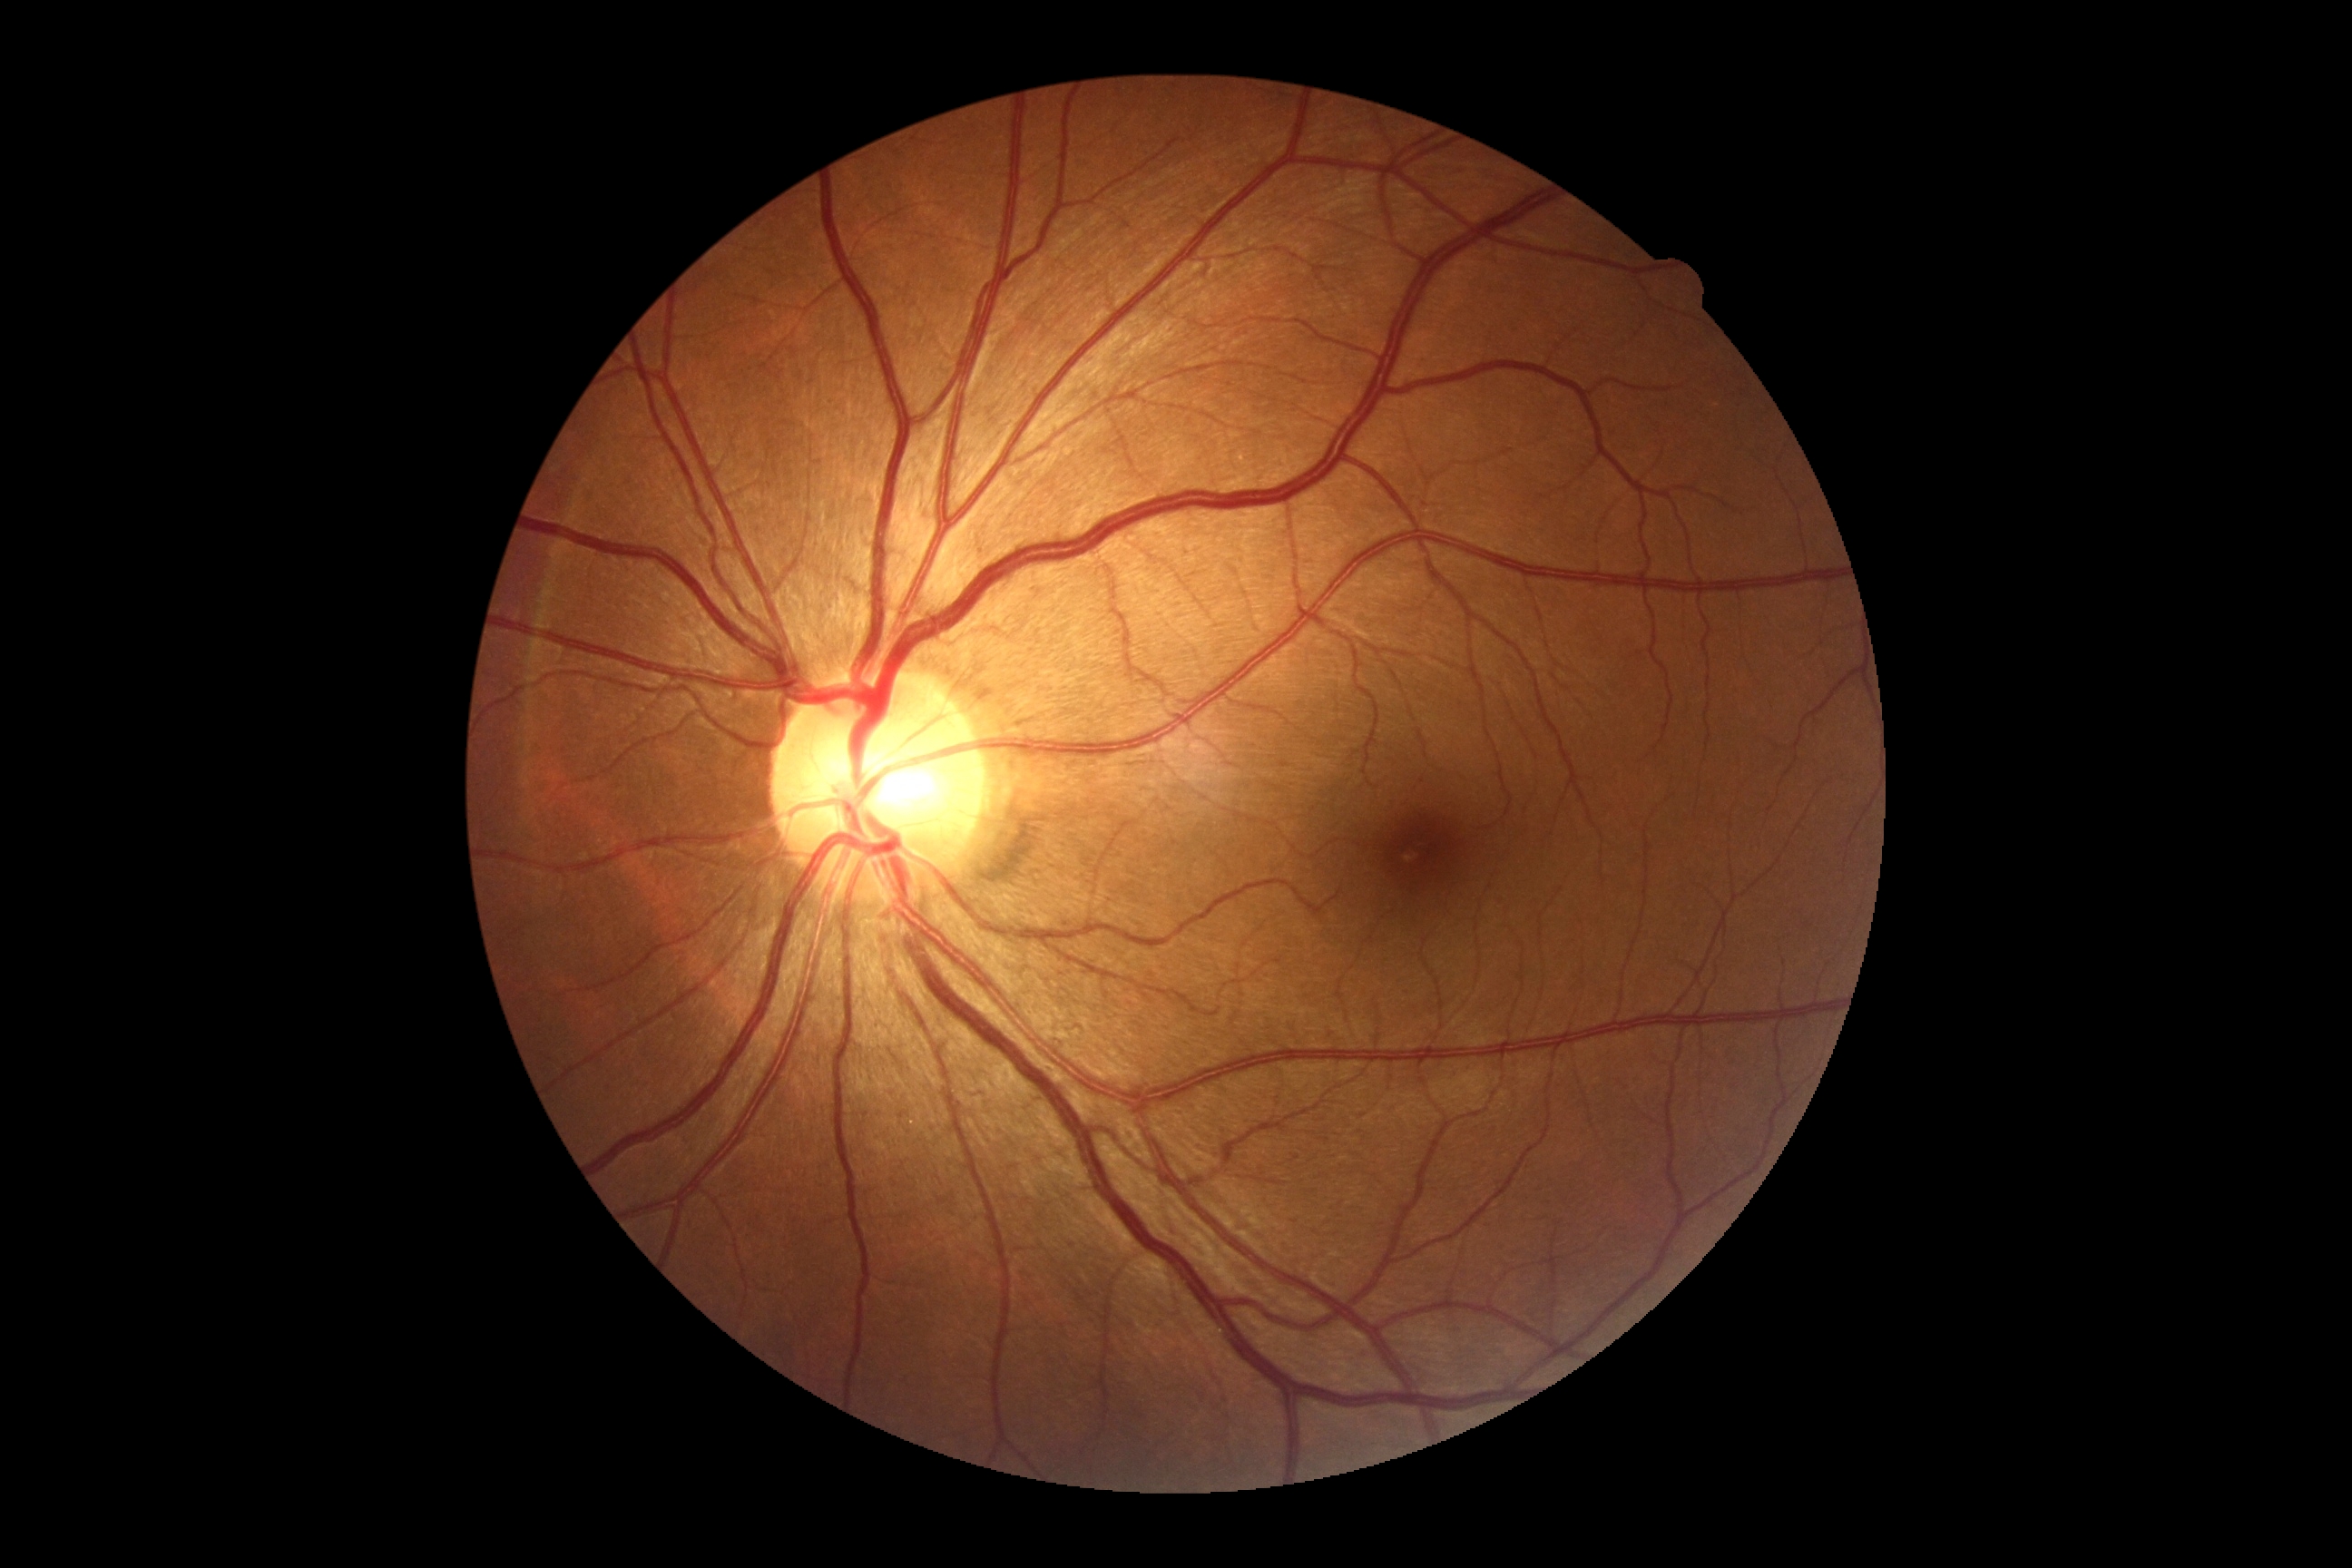   dr_grade: grade 0 (no apparent retinopathy)
  dr_impression: negative for DR